Camera: NIDEK AFC-230. Diabetic retinopathy graded by the modified Davis classification. Fundus photo. Image size 848x848. No pharmacologic dilation. 45° field of view
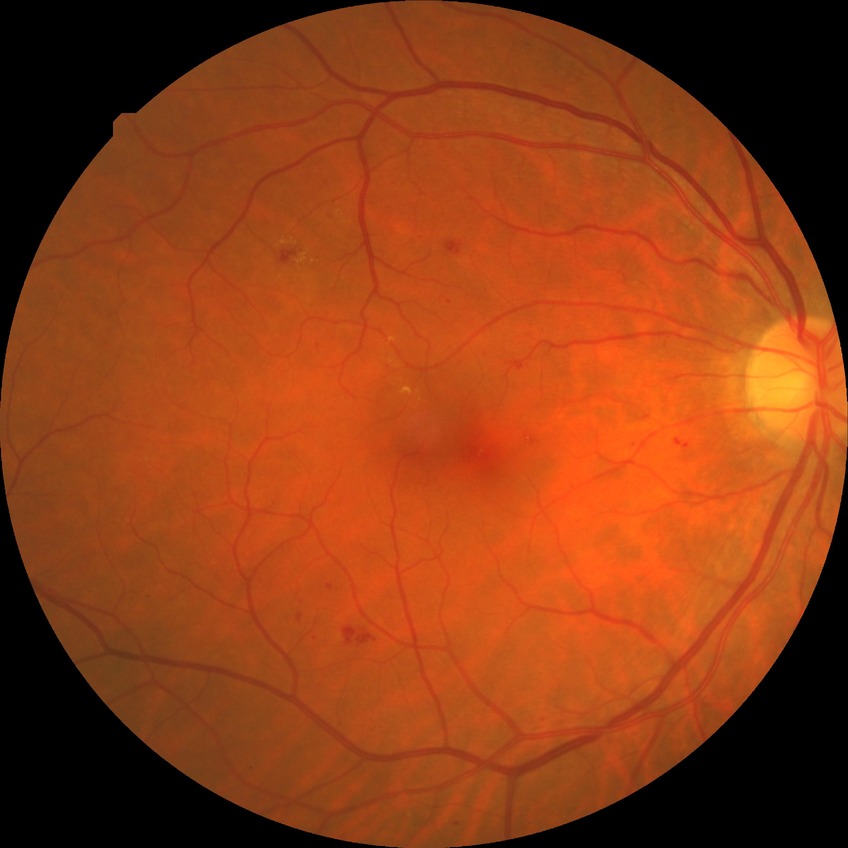

diabetic retinopathy severity = simple diabetic retinopathy